2048x1536px: 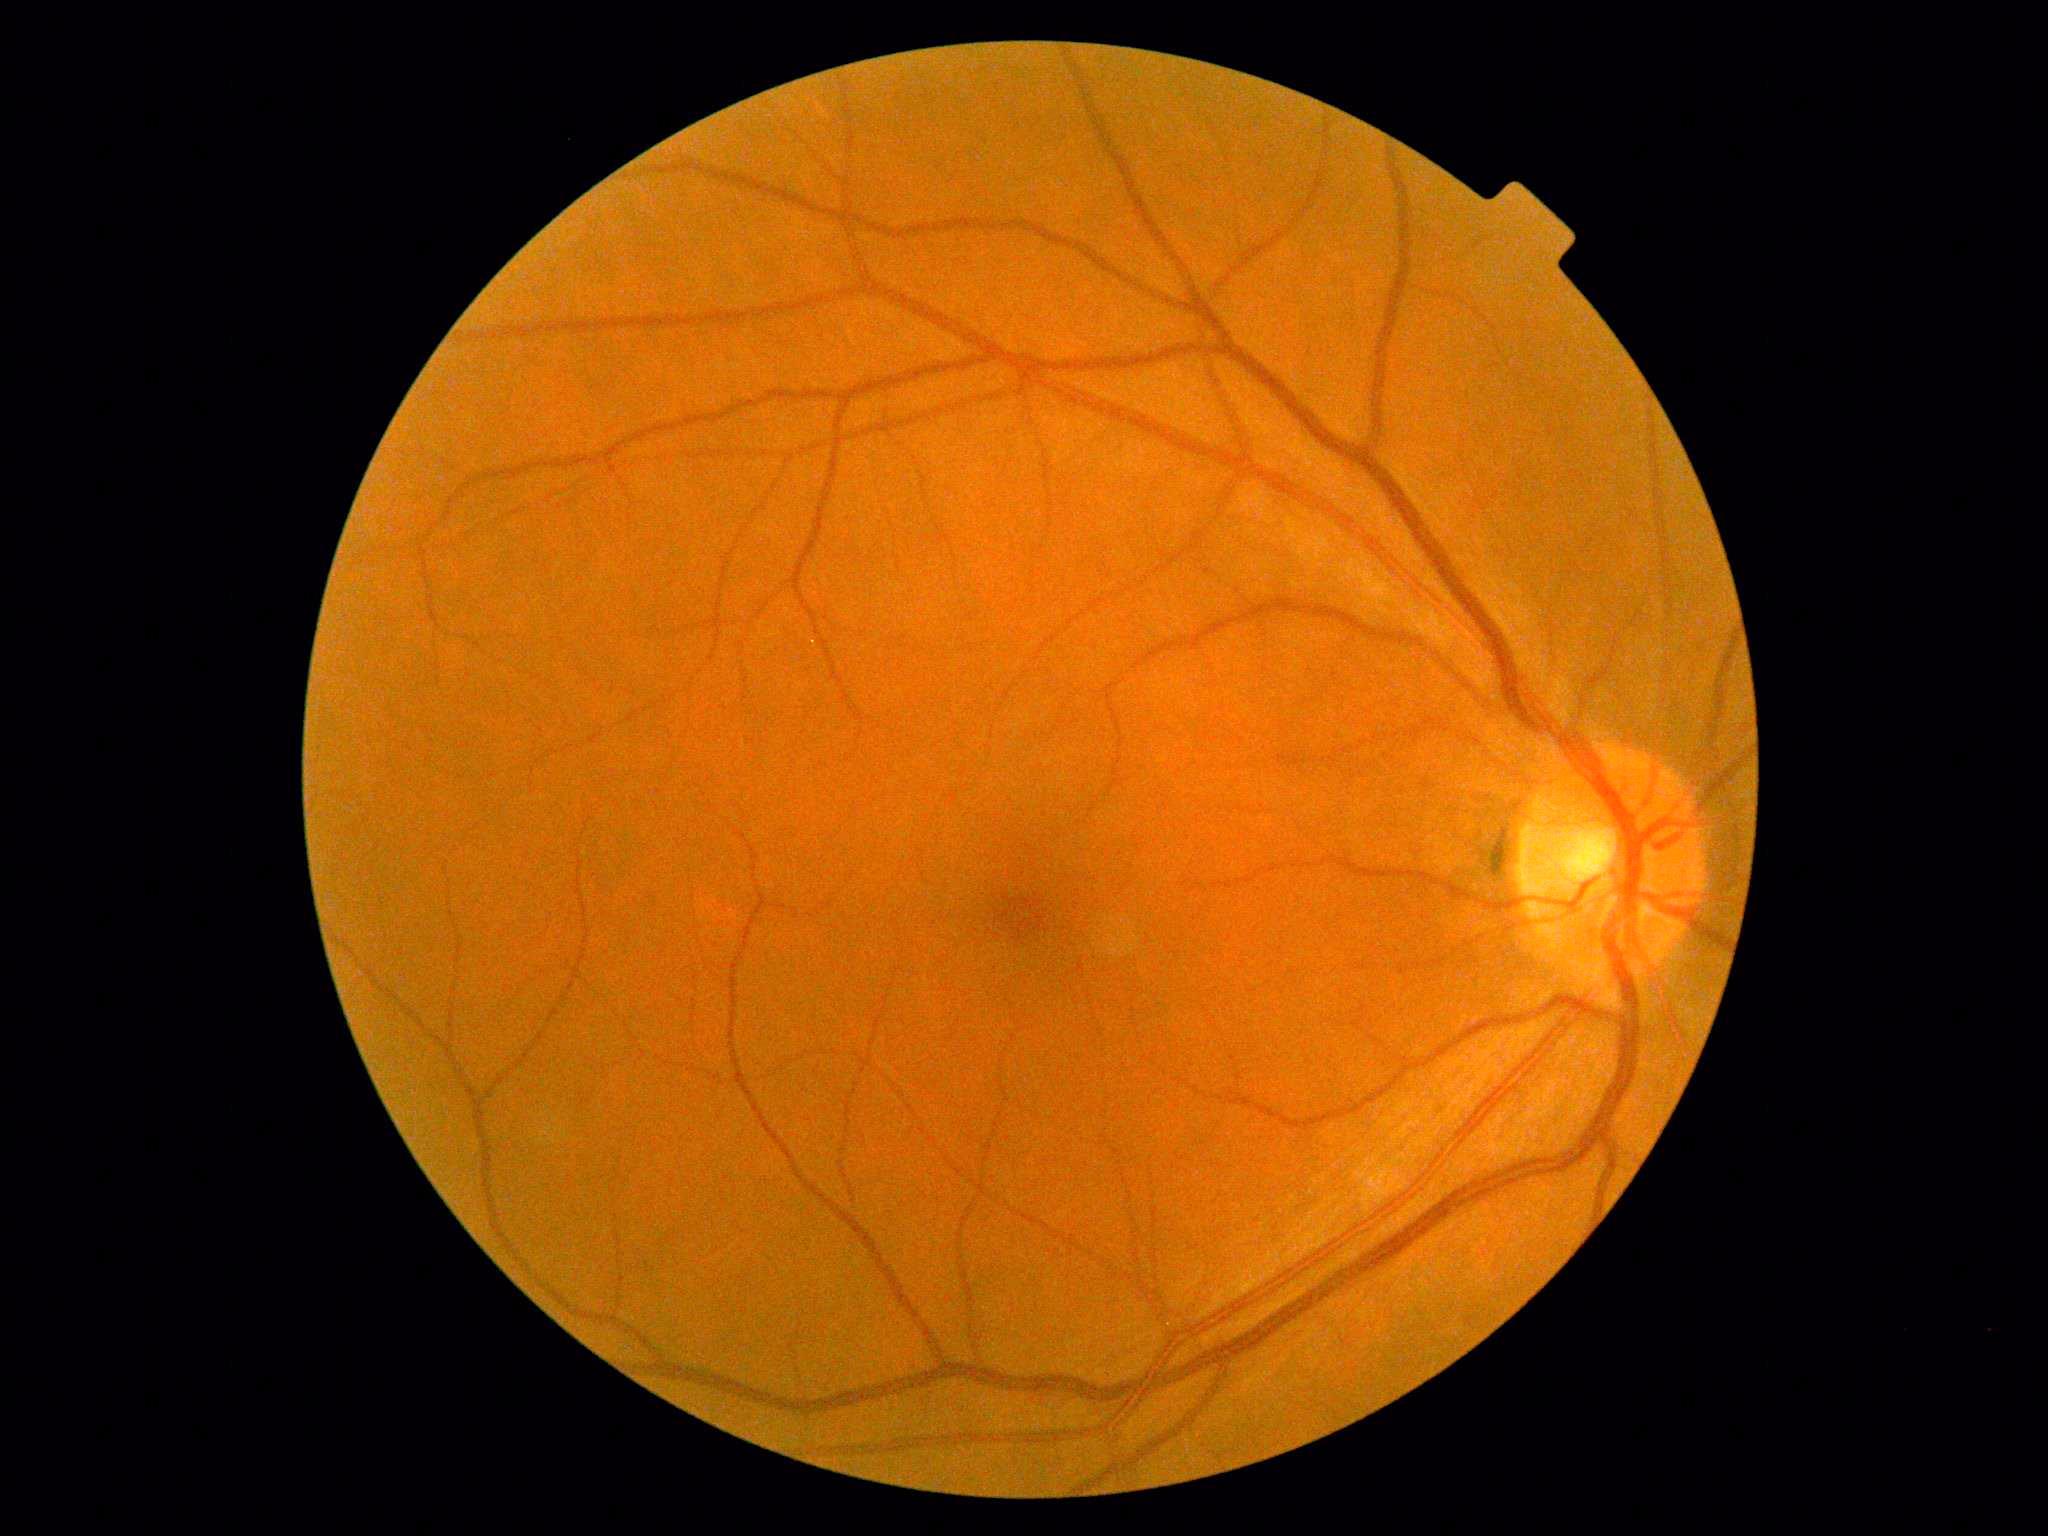 DR impression=no apparent DR; DR=no apparent diabetic retinopathy (grade 0).